ONH-centered crop from a color fundus image: 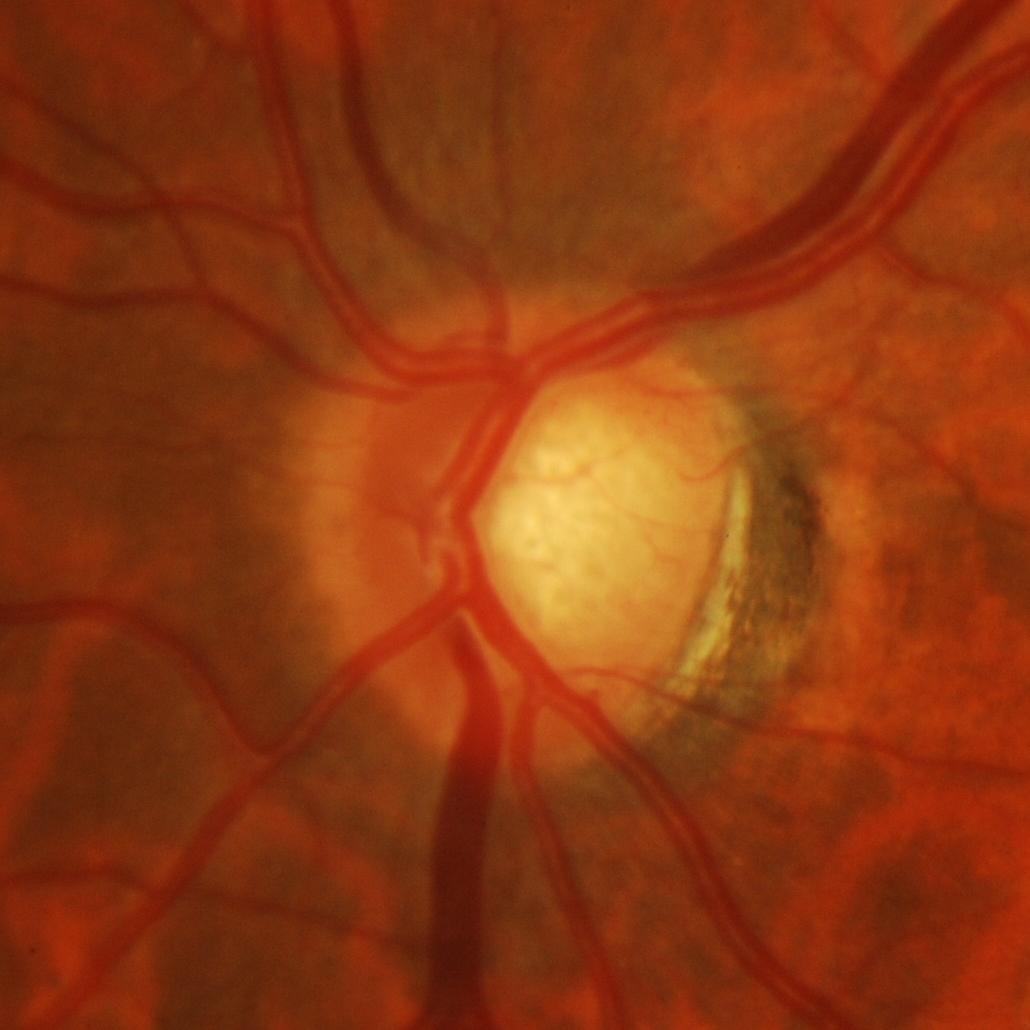 Q: What is the glaucoma diagnosis?
A: Yes — glaucomatous changes.